1920 by 1440 pixels. Acquired with a Bosch handheld camera. CFP — 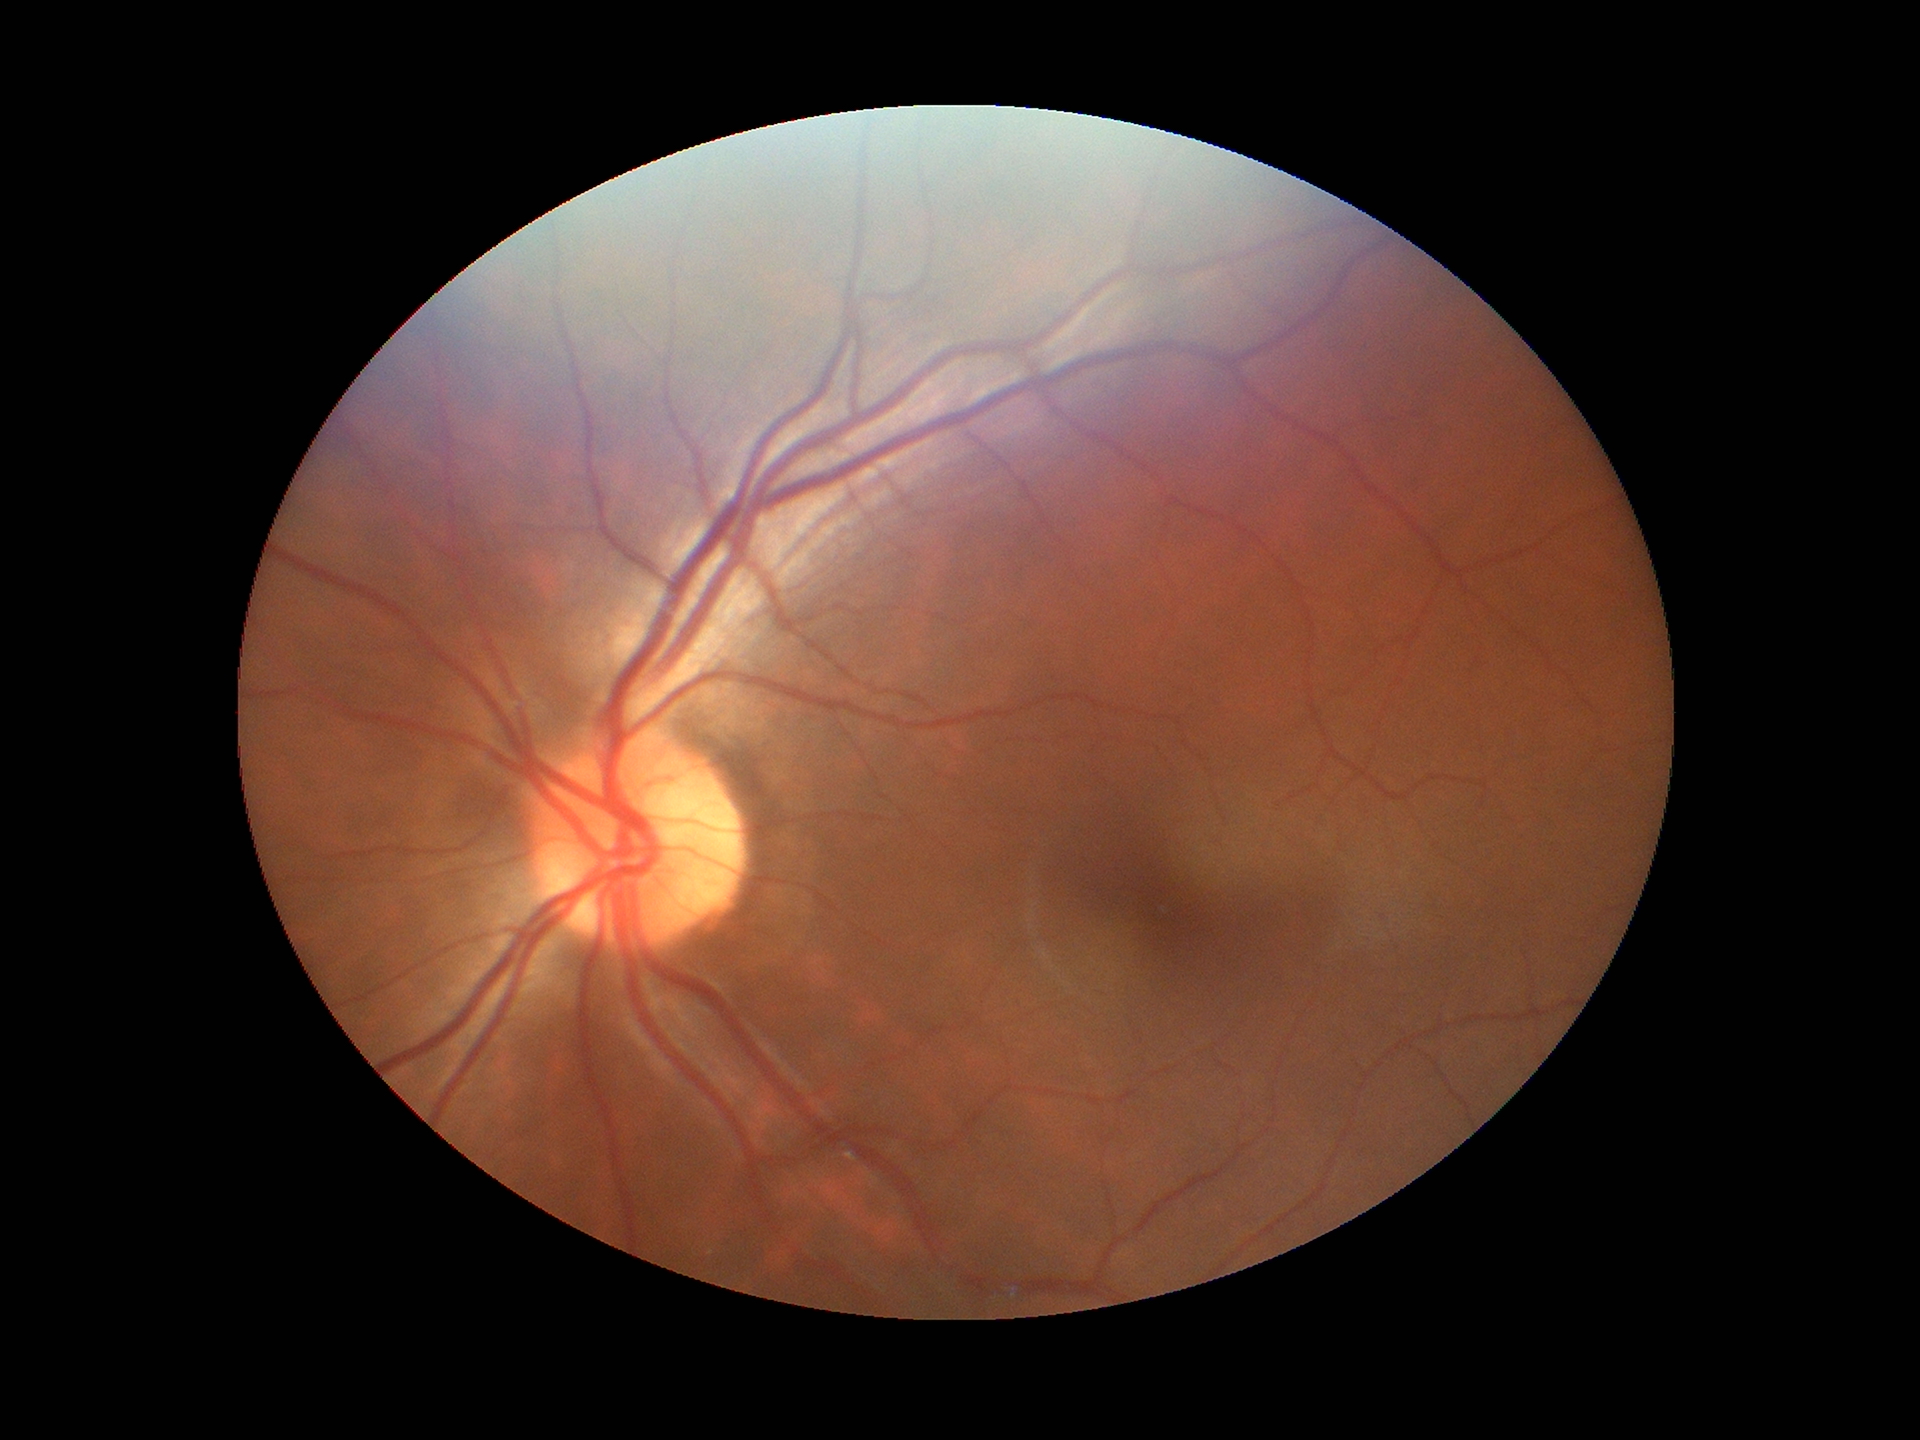
area cup-to-disc ratio (ACDR) = 0.20 | Glaucoma impression = no suspicious findings | vertical CDR (VCDR) = 0.43.